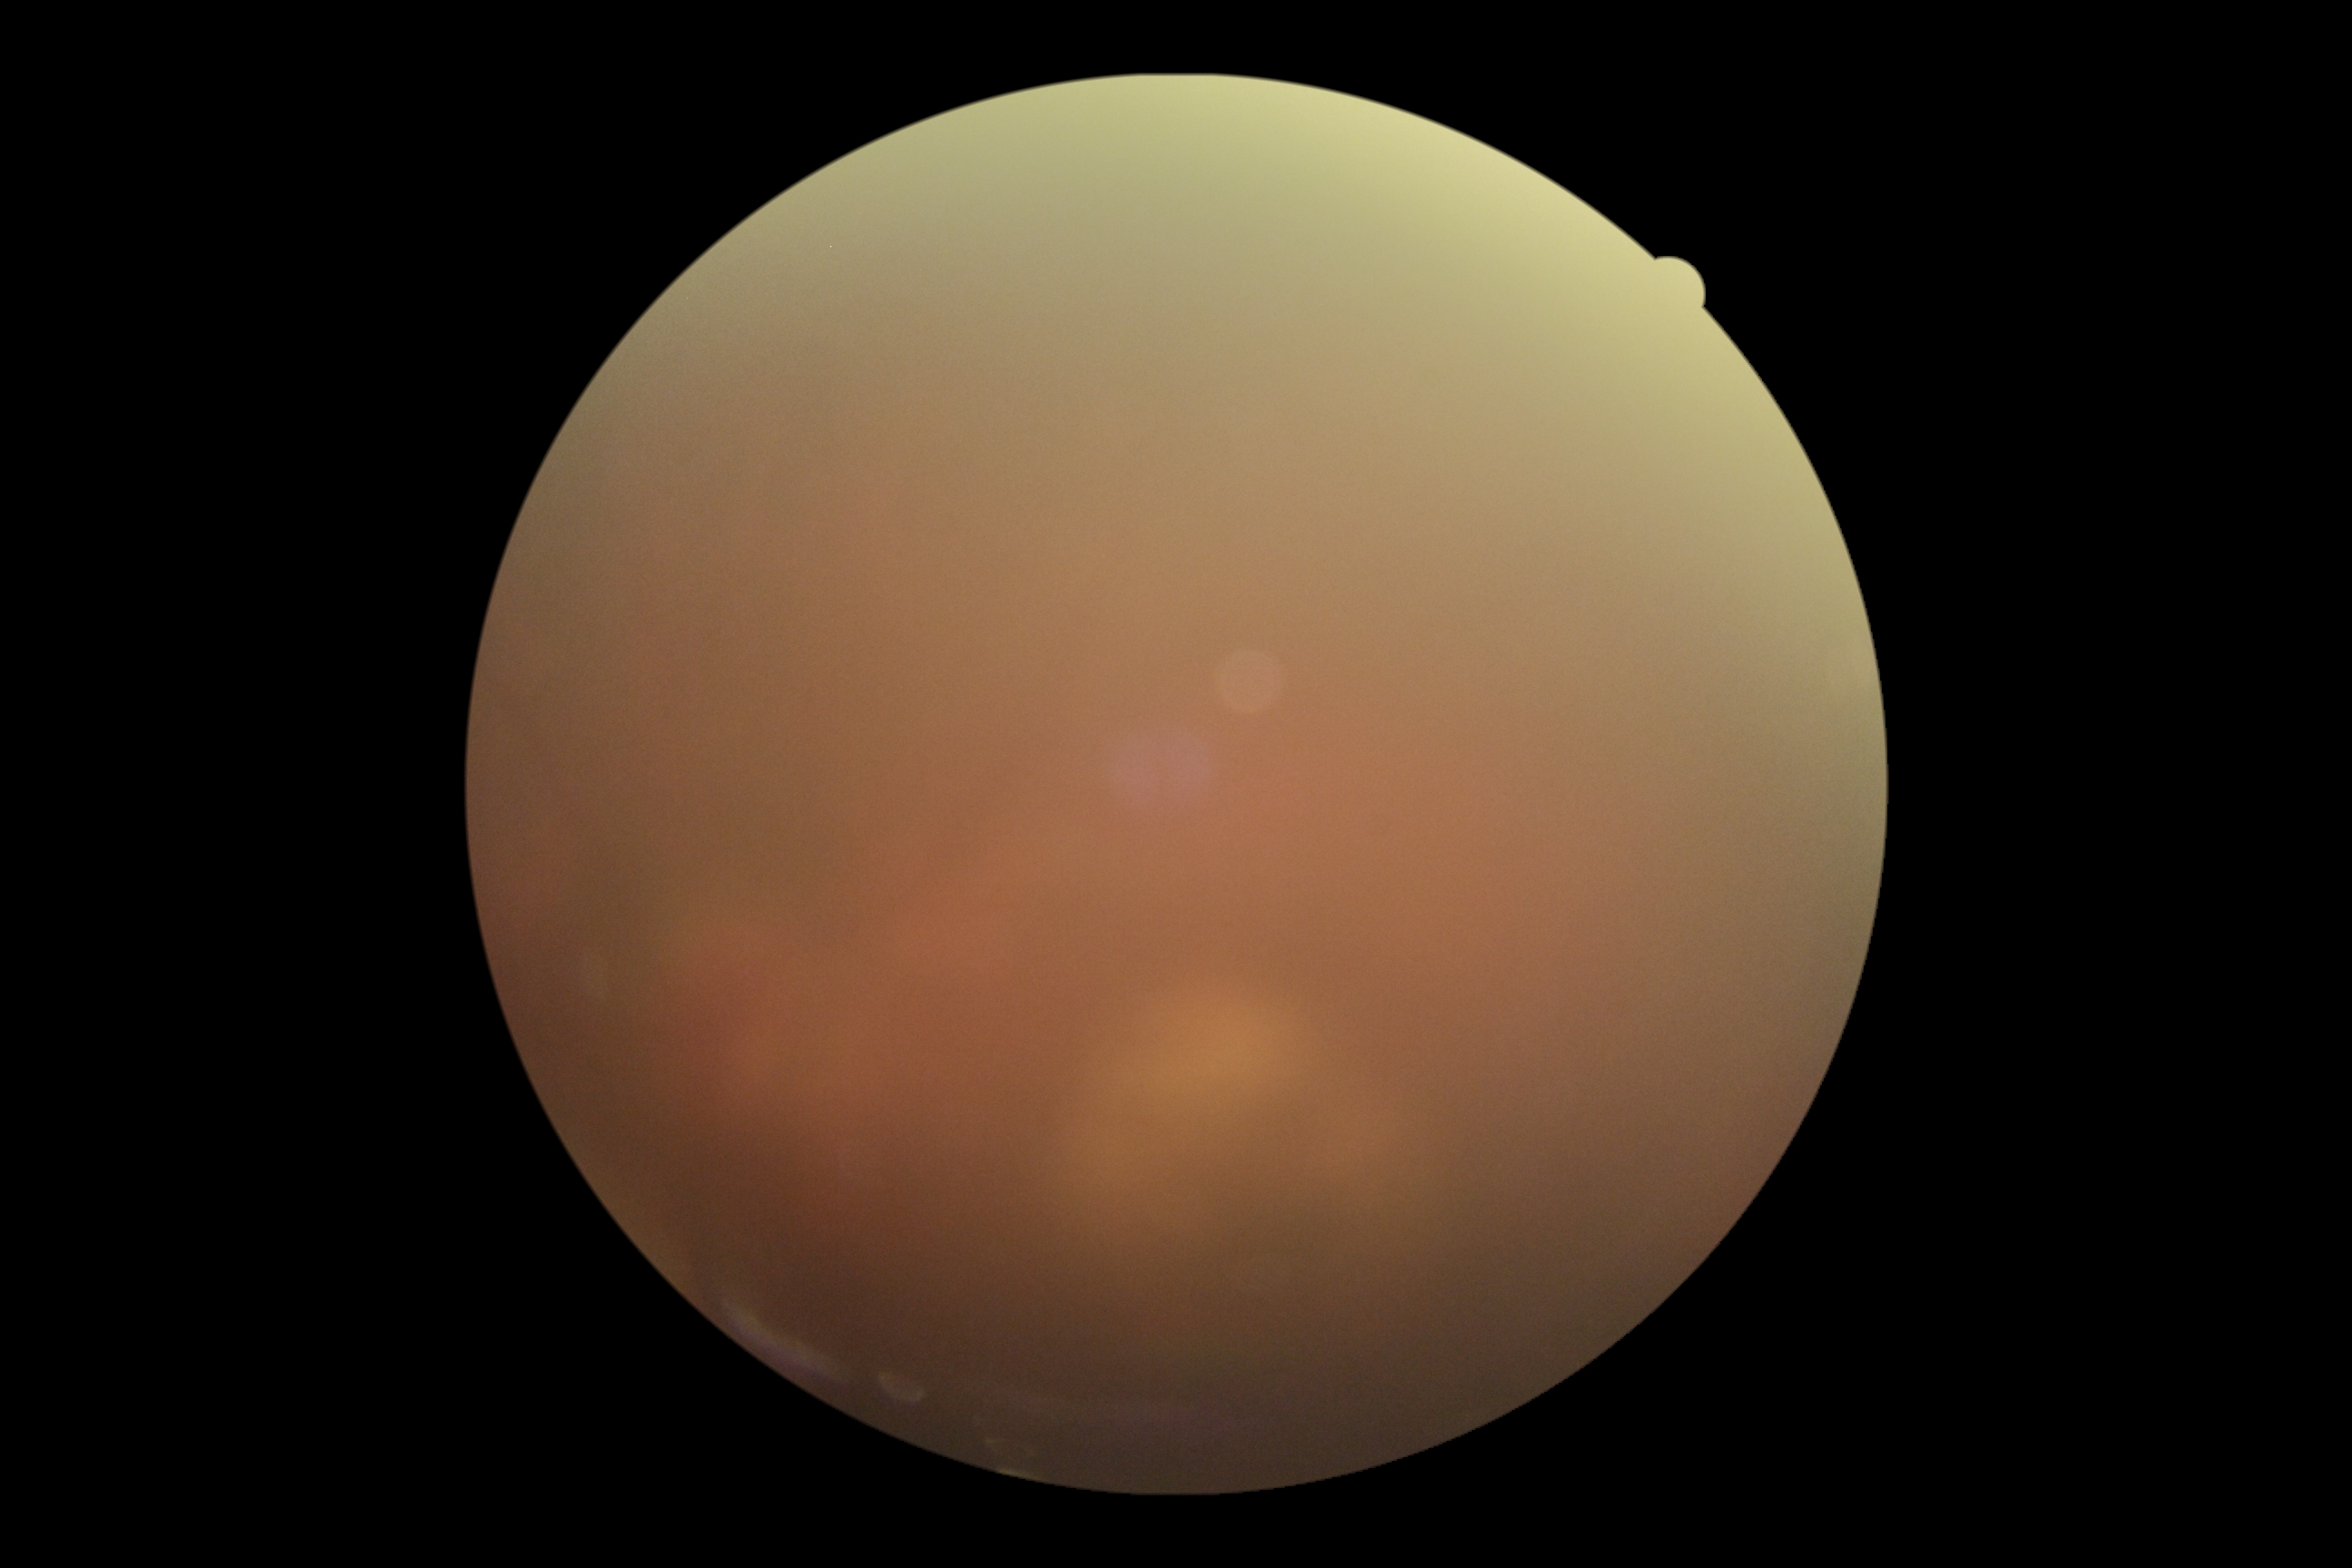
DR = ungradable, image quality = insufficient.